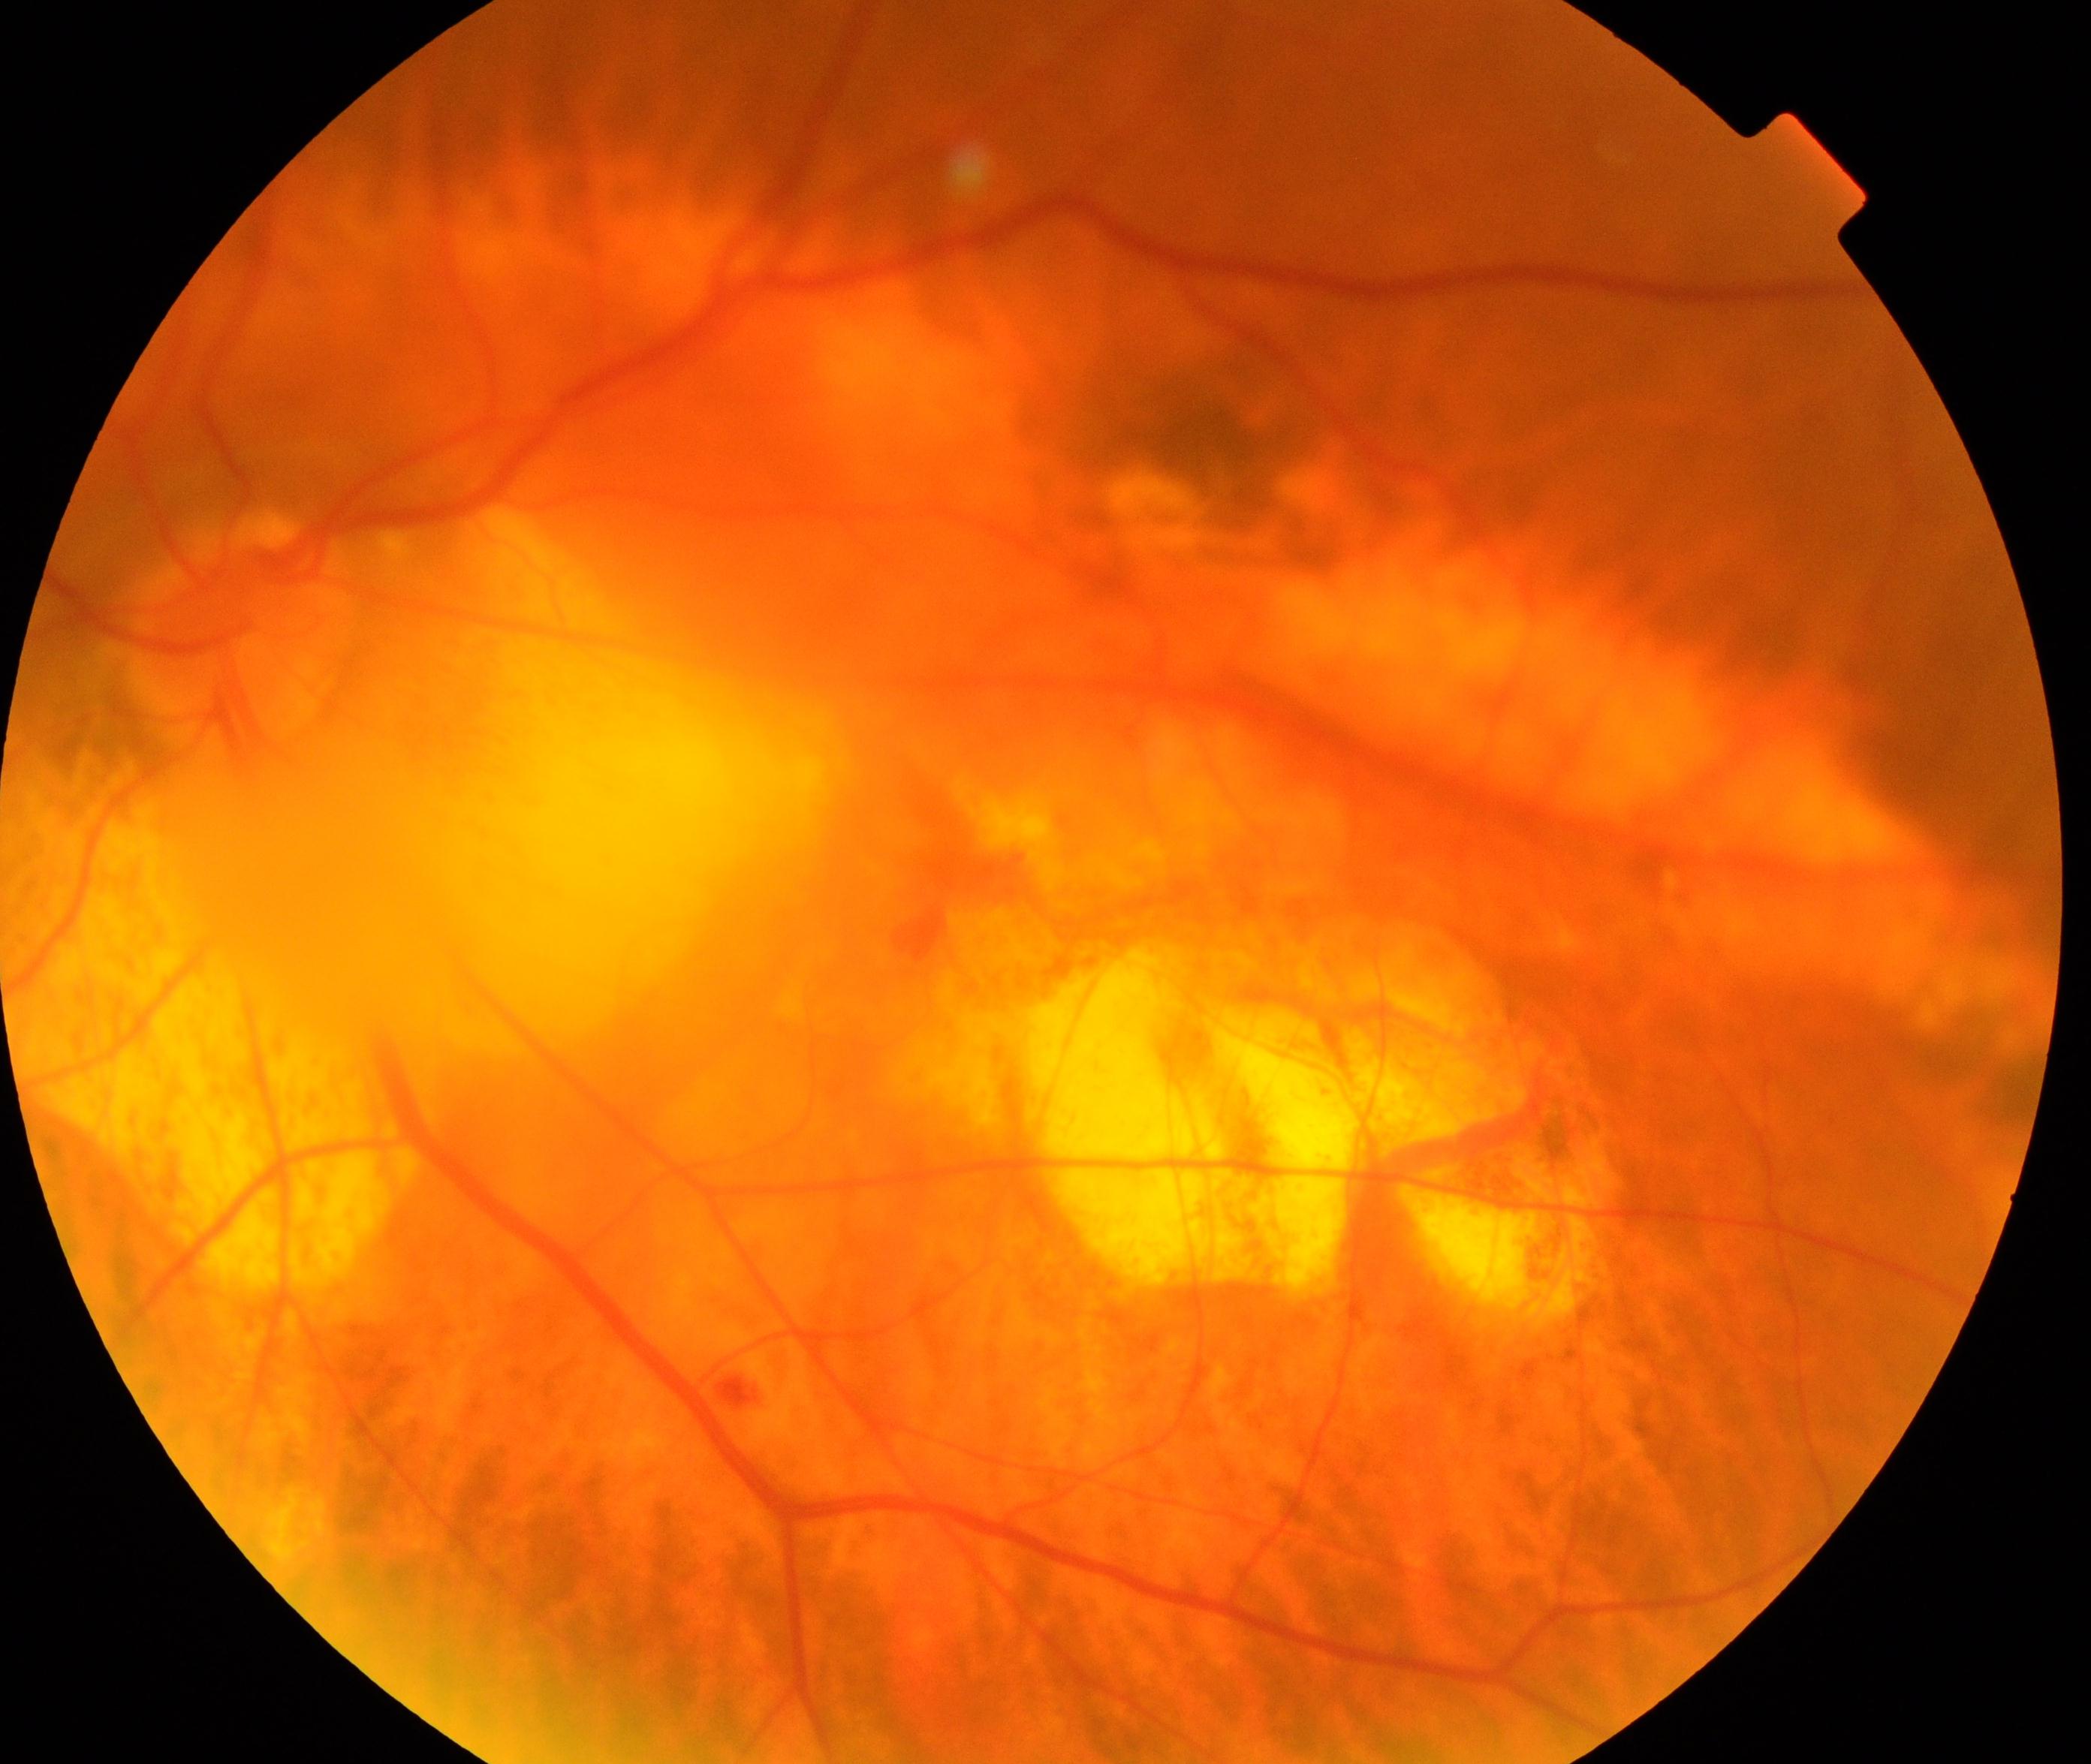 This fundus photograph shows pathological myopia.